200° FOV:
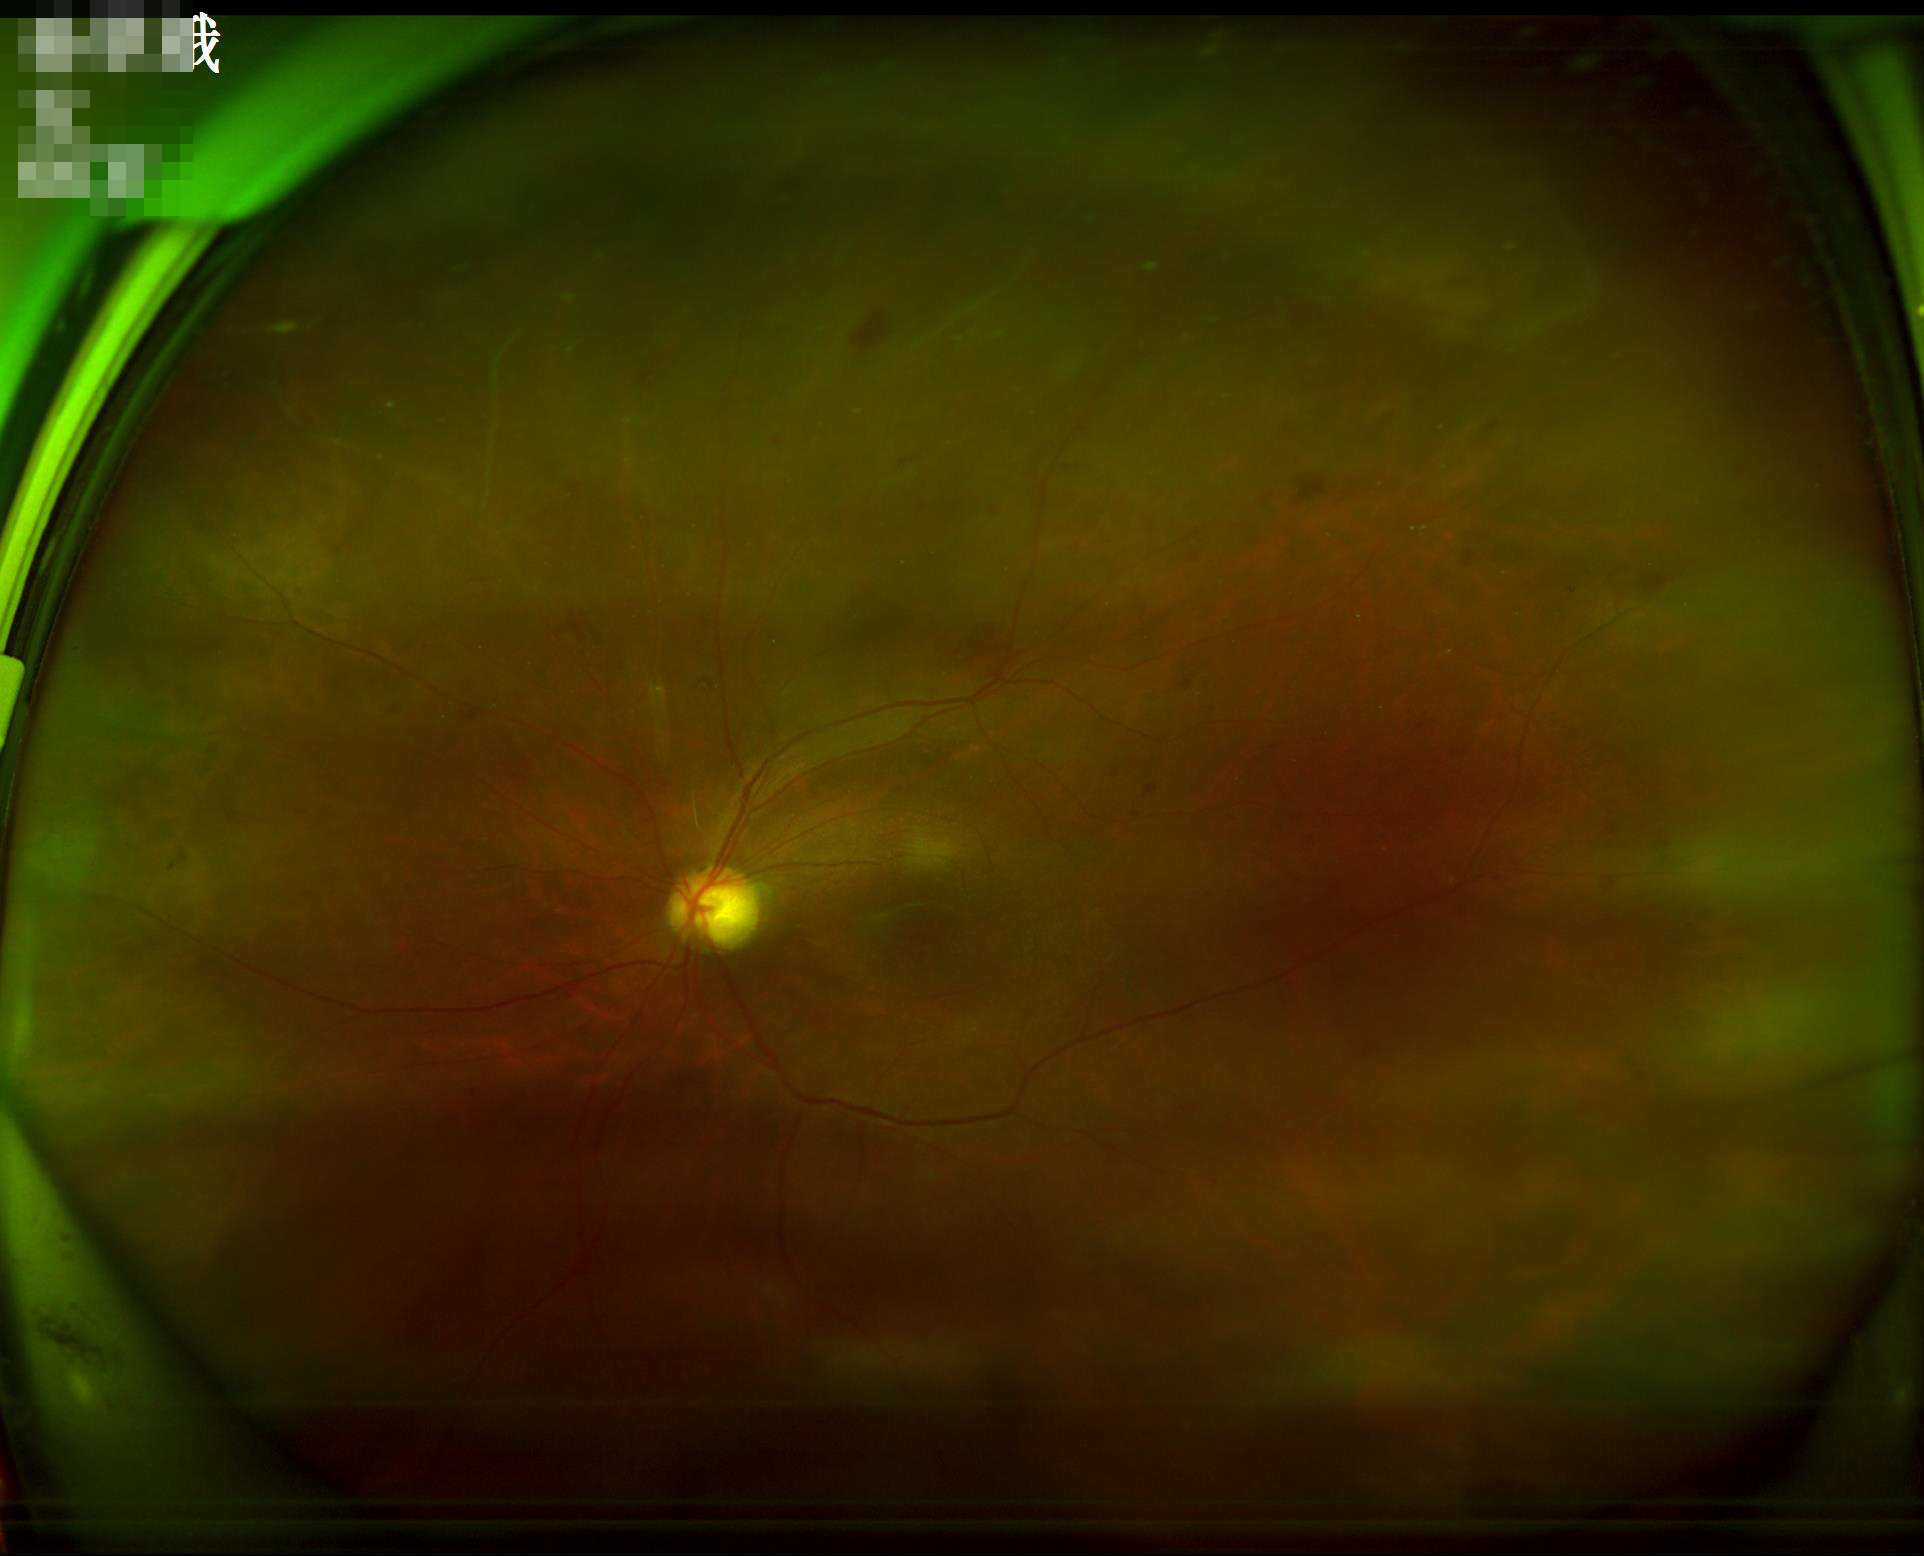

Noticeable blur in the optic disc, vessels, or background.
Good dynamic range.
Even illumination with no color cast.
Overall quality is poor; the image is difficult to grade.